Color fundus image — 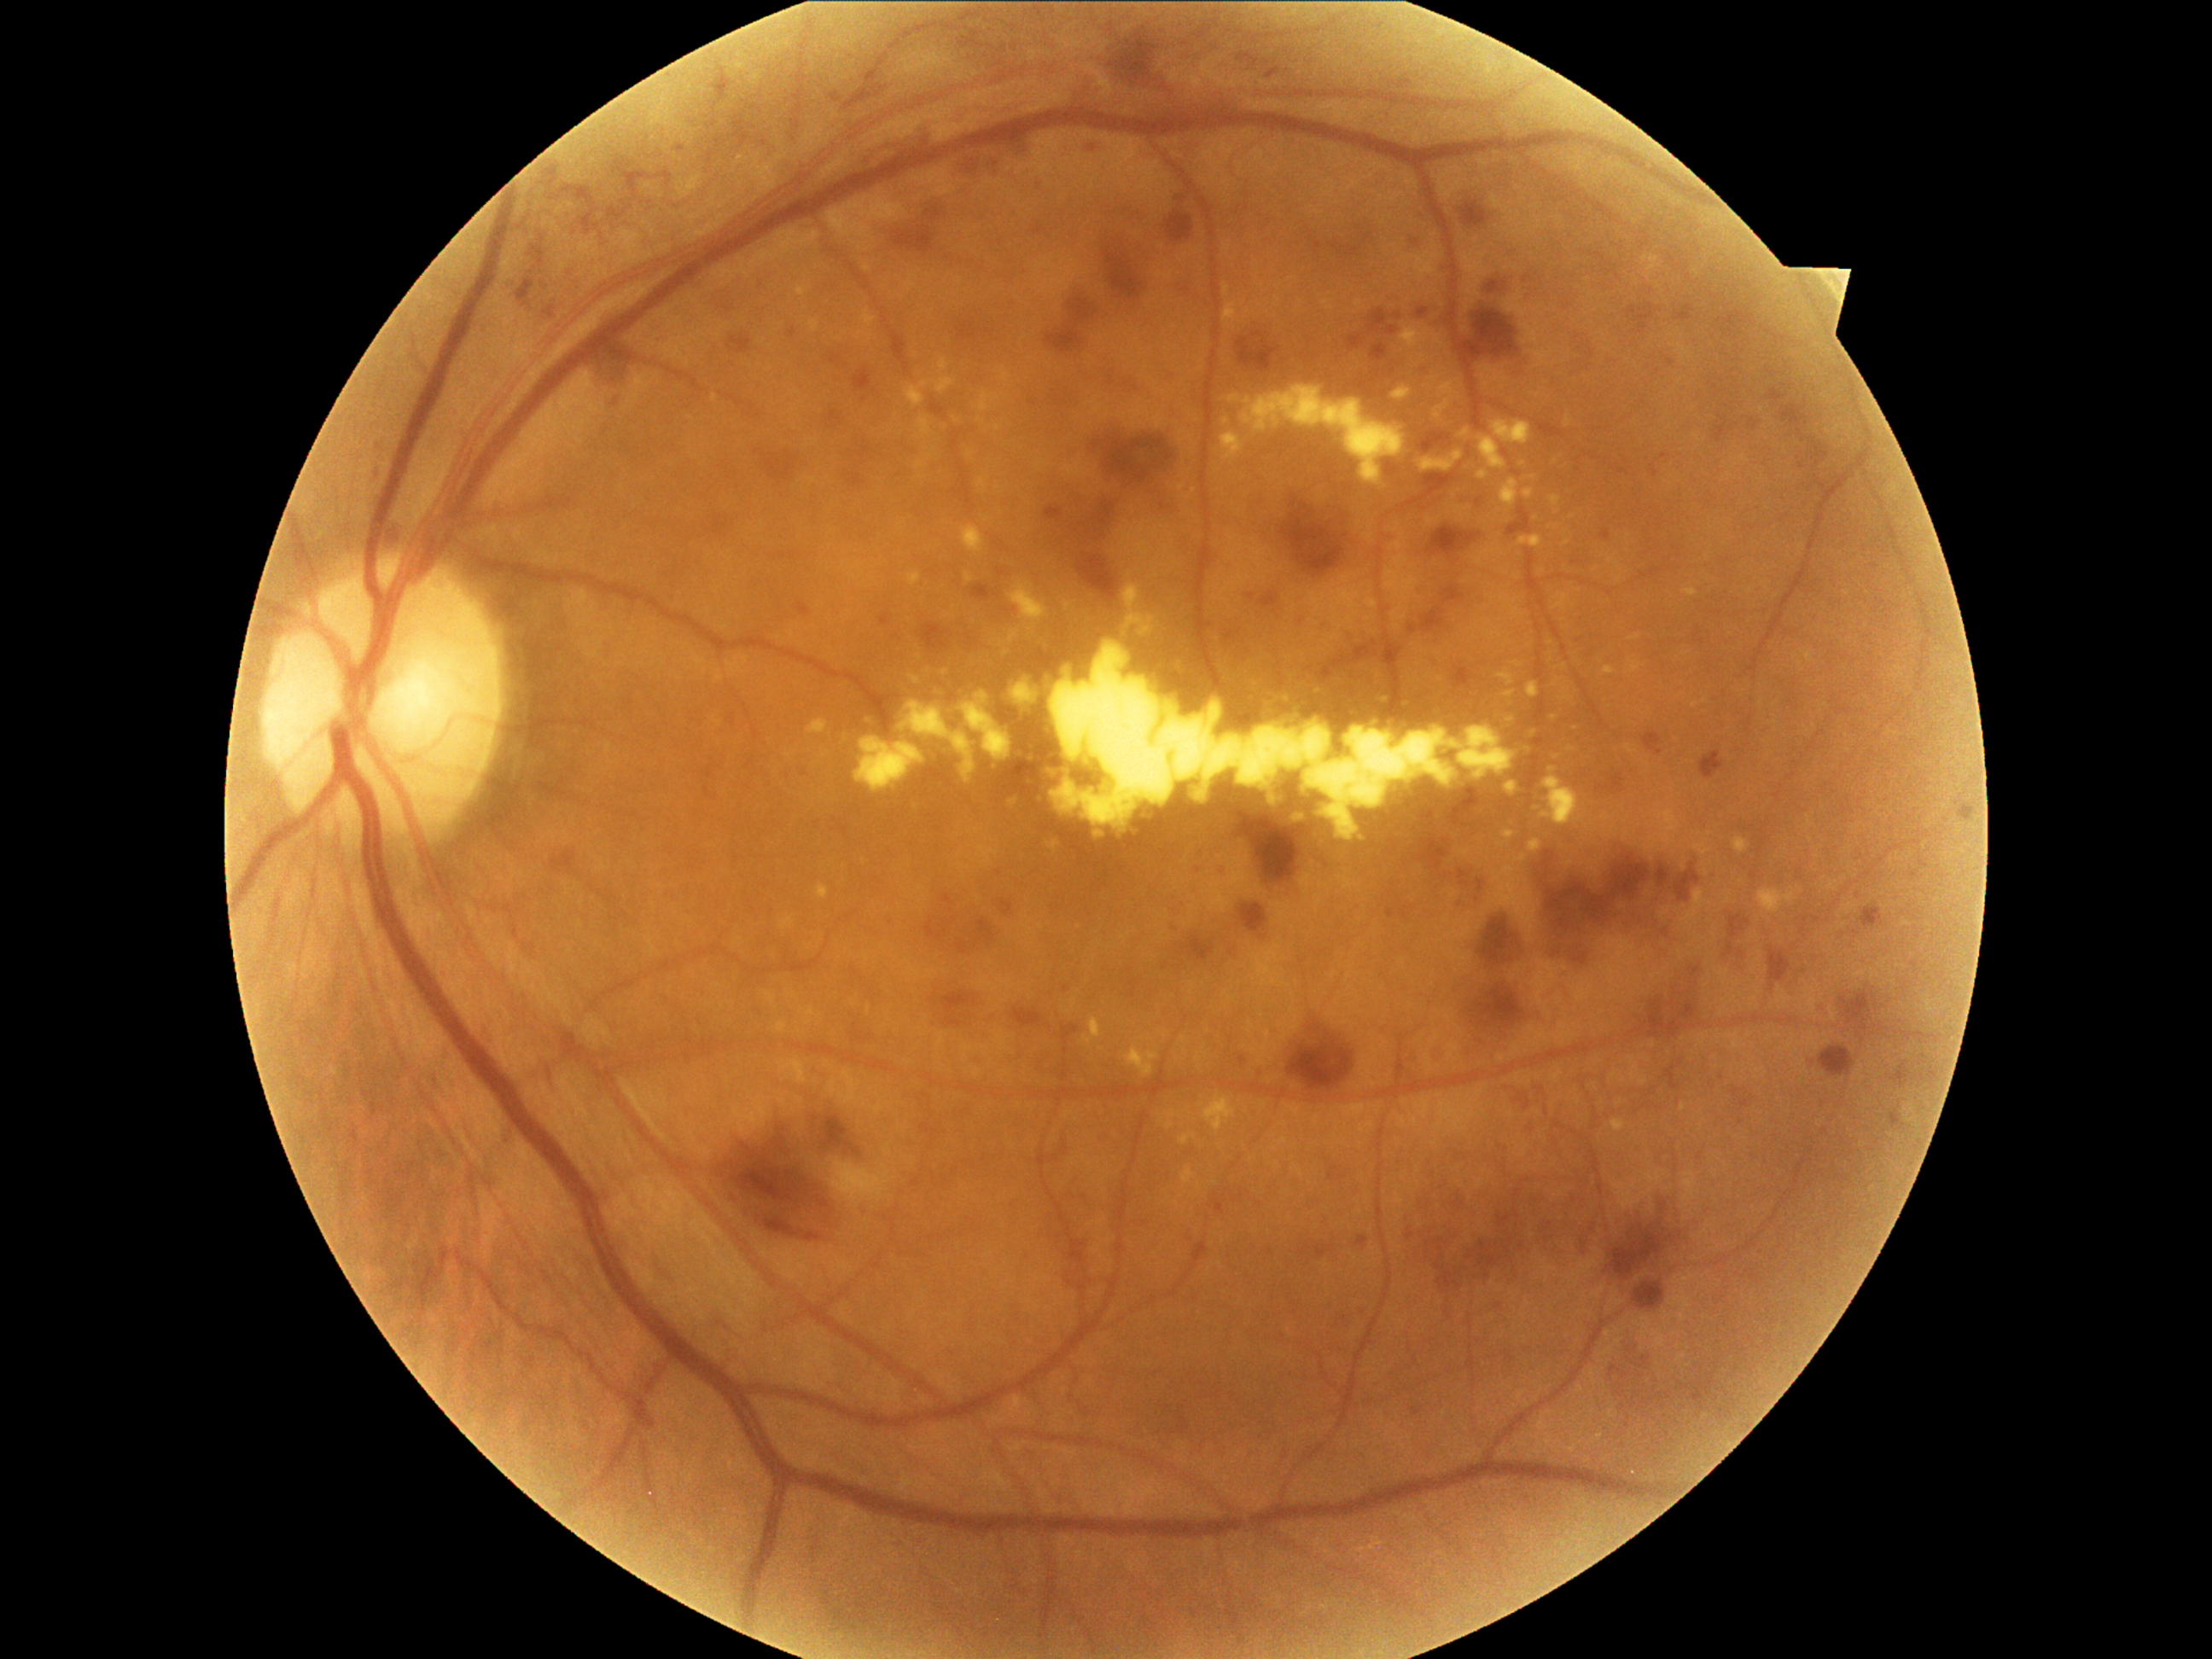
{"partial": true, "dr_grade": 3, "dr_grade_name": "severe NPDR", "lesions": {"he": [[1033, 503, 1059, 518], [1528, 269, 1540, 291], [1602, 528, 1612, 540], [1467, 303, 1522, 361], [1349, 334, 1366, 347], [1220, 868, 1225, 880], [1011, 1008, 1051, 1028], [941, 894, 955, 905], [1423, 607, 1443, 634], [1003, 762, 1044, 803], [1269, 489, 1356, 568], [1102, 242, 1141, 303], [1165, 209, 1194, 243], [957, 320, 996, 342], [1218, 608, 1254, 646], [975, 583, 999, 597]], "he_small_centers": [[1187, 901]]}}